2352 x 1568 pixels. 45-degree field of view. Fundus photo: 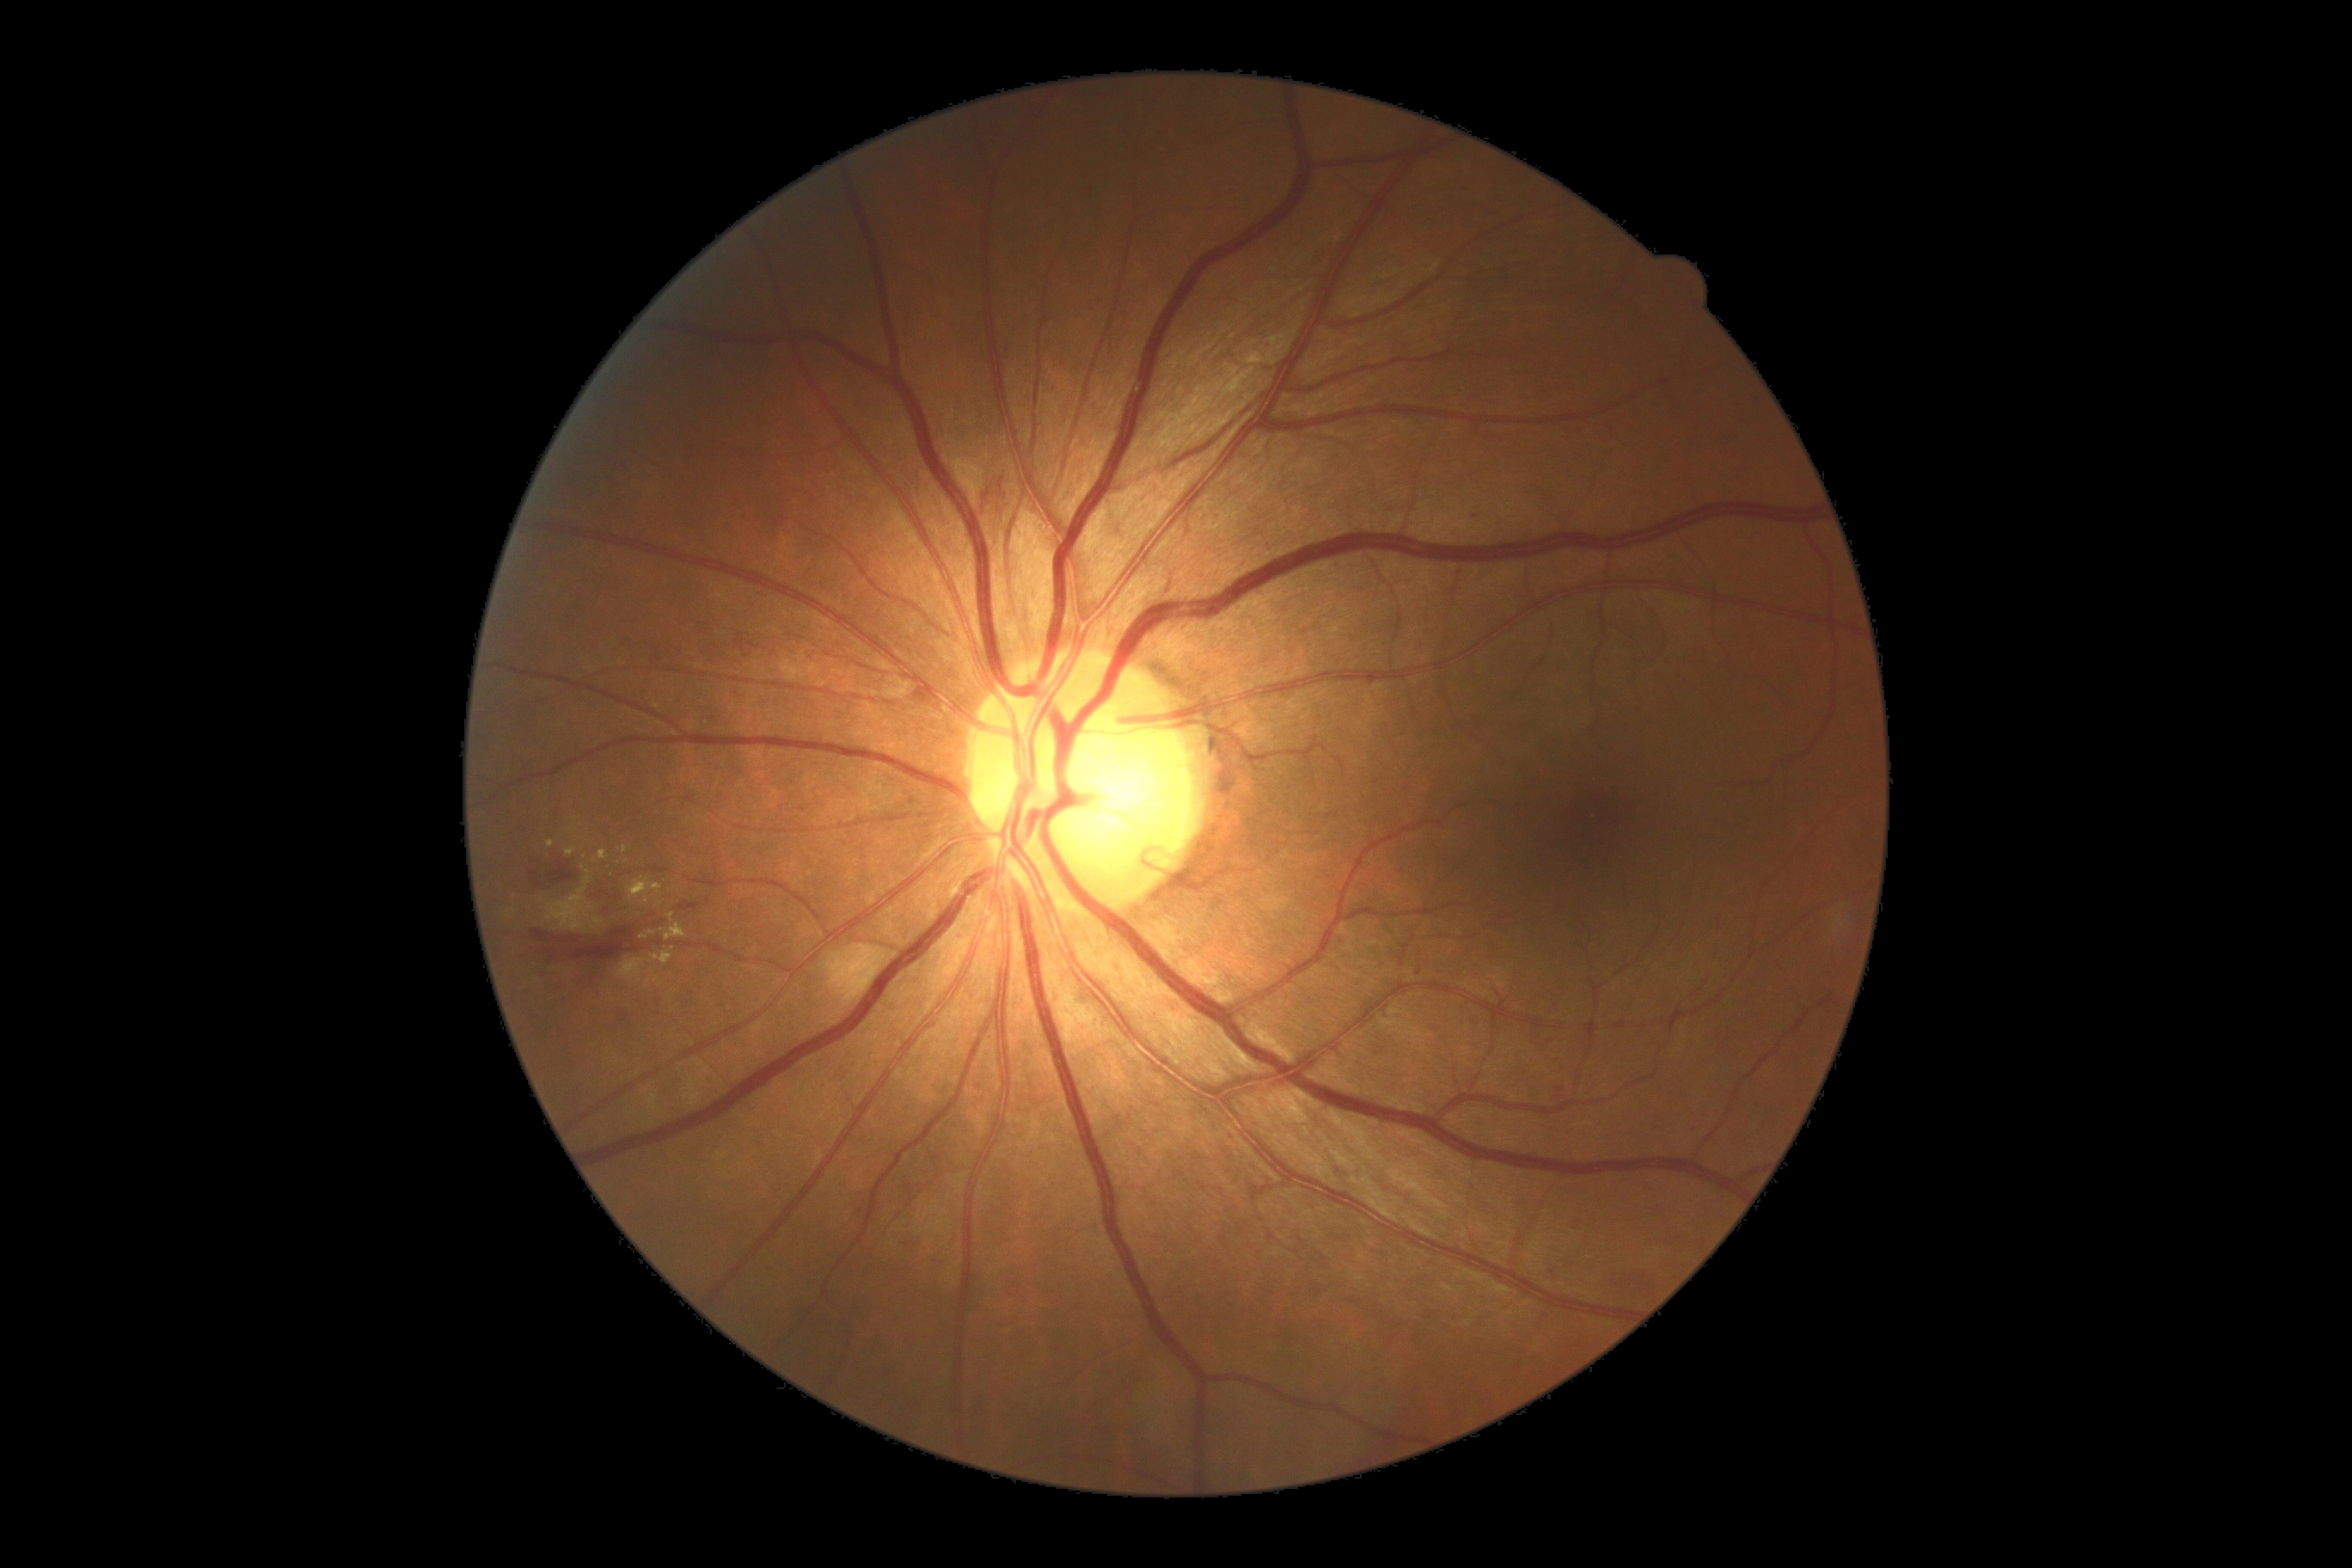
{"partial": true, "dr_grade": 2, "dr_grade_name": "moderate NPDR", "lesions": {"he": [[524, 864, 570, 891], [601, 905, 613, 916], [580, 962, 601, 984], [735, 634, 749, 651], [1555, 1087, 1564, 1101], [678, 903, 699, 912], [537, 931, 632, 959], [981, 487, 1005, 510], [591, 885, 611, 898], [615, 881, 627, 898]], "ma": [[1414, 967, 1421, 976]], "ma_small_centers": [[802, 810], [1476, 516]], "ex": [[594, 850, 608, 862], [628, 878, 663, 905], [651, 948, 675, 965], [565, 847, 577, 857], [665, 924, 687, 941]], "ex_small_centers": [[625, 850], [551, 845], [620, 864], [652, 933], [663, 931], [643, 938], [671, 917]], "se": [[544, 871, 592, 933], [616, 959, 646, 984]]}}